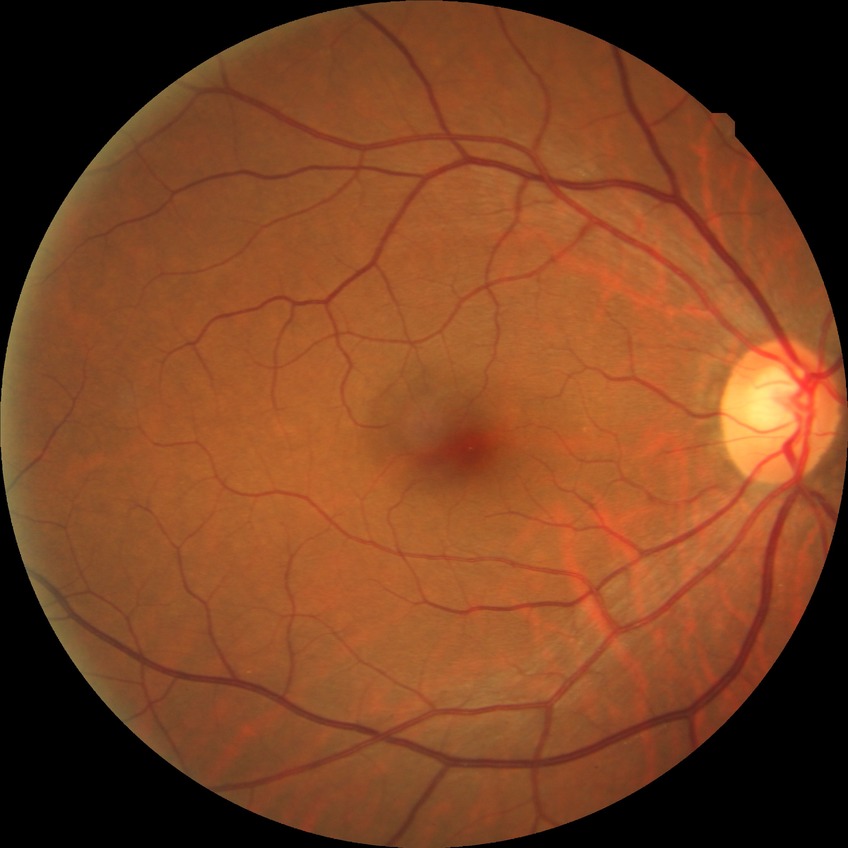

diabetic retinopathy (DR)@no diabetic retinopathy (NDR).